Modified Davis grading
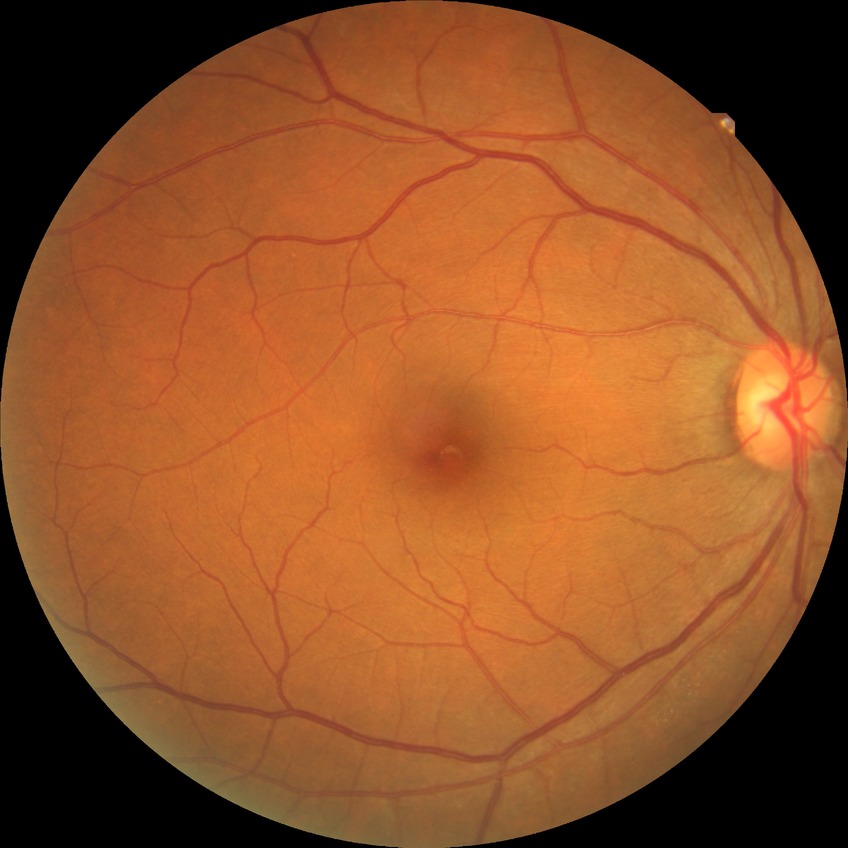
Diabetic retinopathy (DR) is NDR (no diabetic retinopathy).